Camera: NIDEK AFC-230; color fundus image; 848x848px; no pharmacologic dilation; 45° field of view: 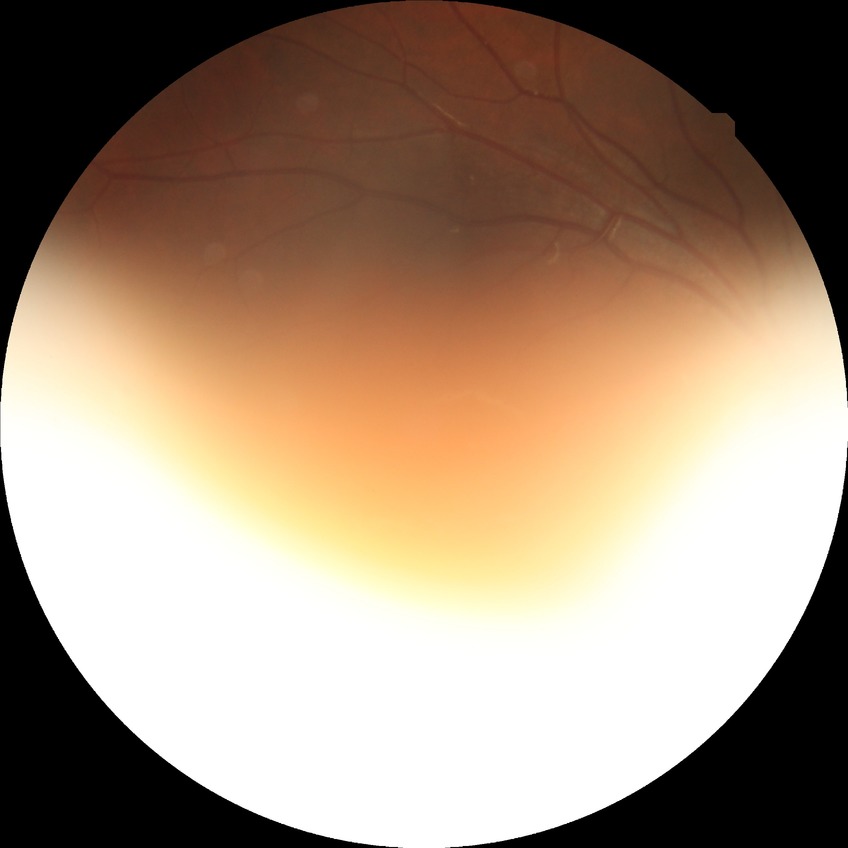 Diabetic retinopathy (DR) is NDR (no diabetic retinopathy).